Color fundus image: 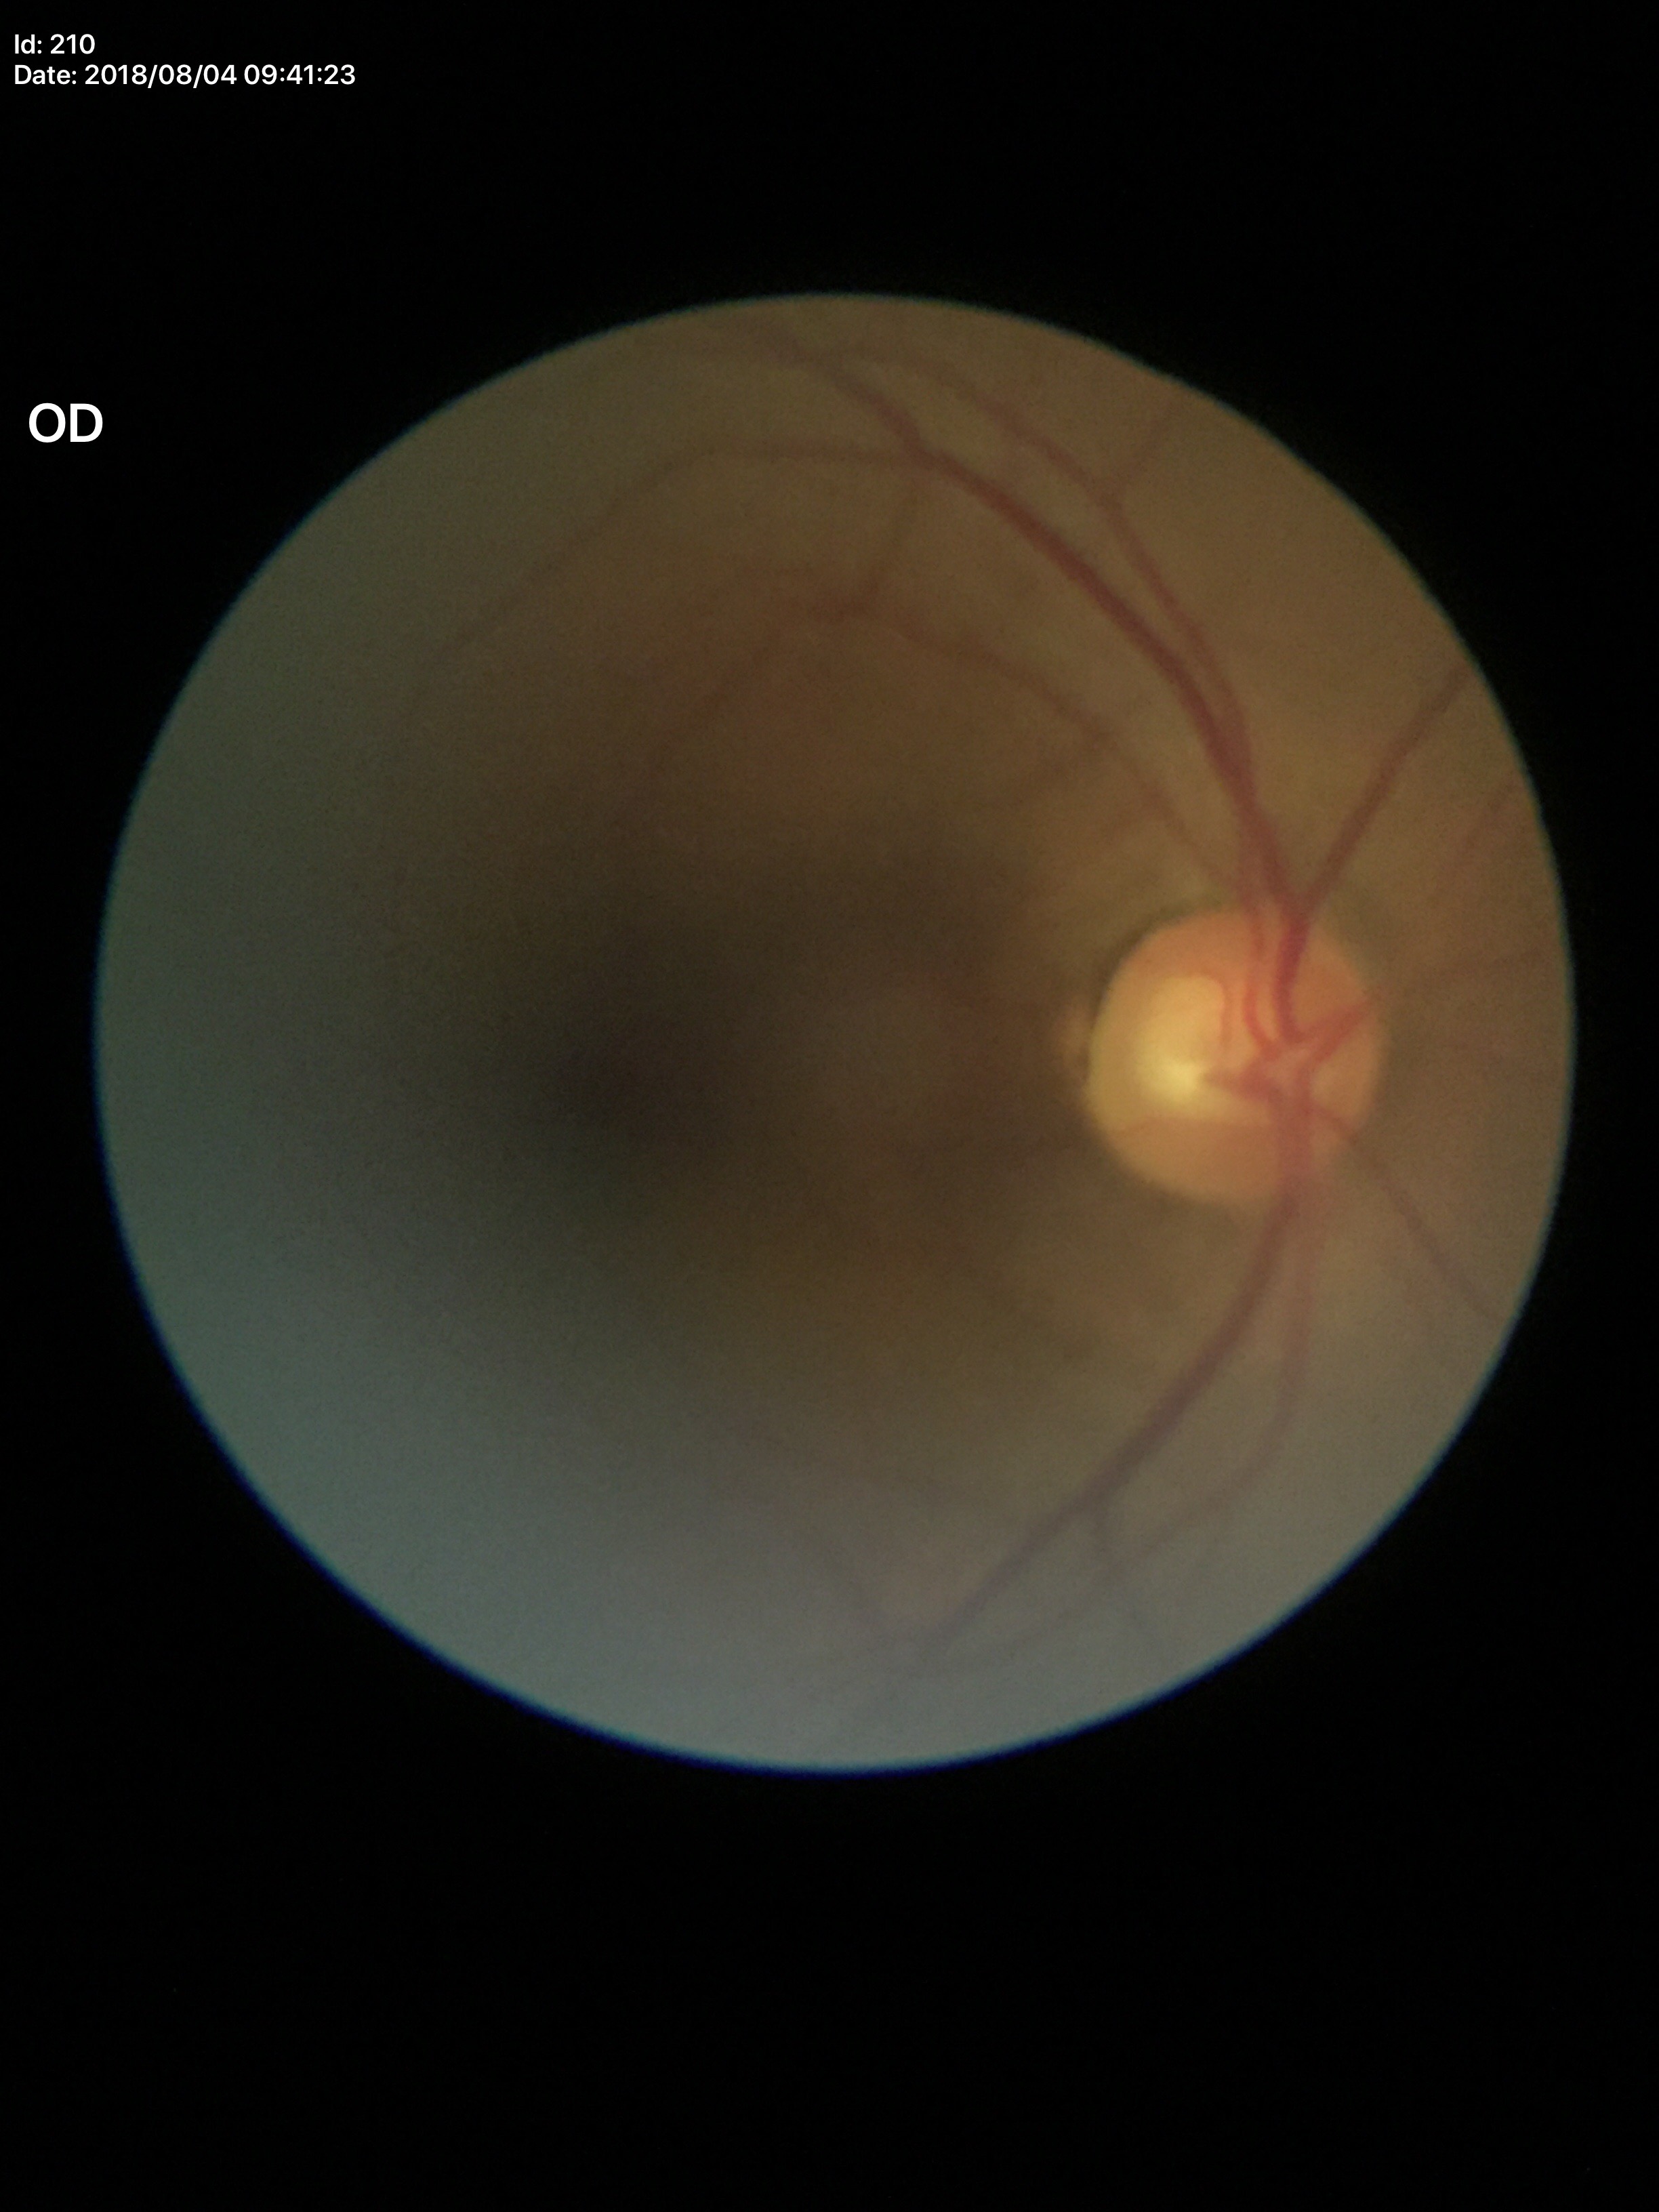
Glaucoma evaluation: not suspect (two of five ophthalmologists flagged glaucoma suspect).
Vertical cup-to-disc ratio is 0.60.
Horizontal cup-disc ratio of 0.69.